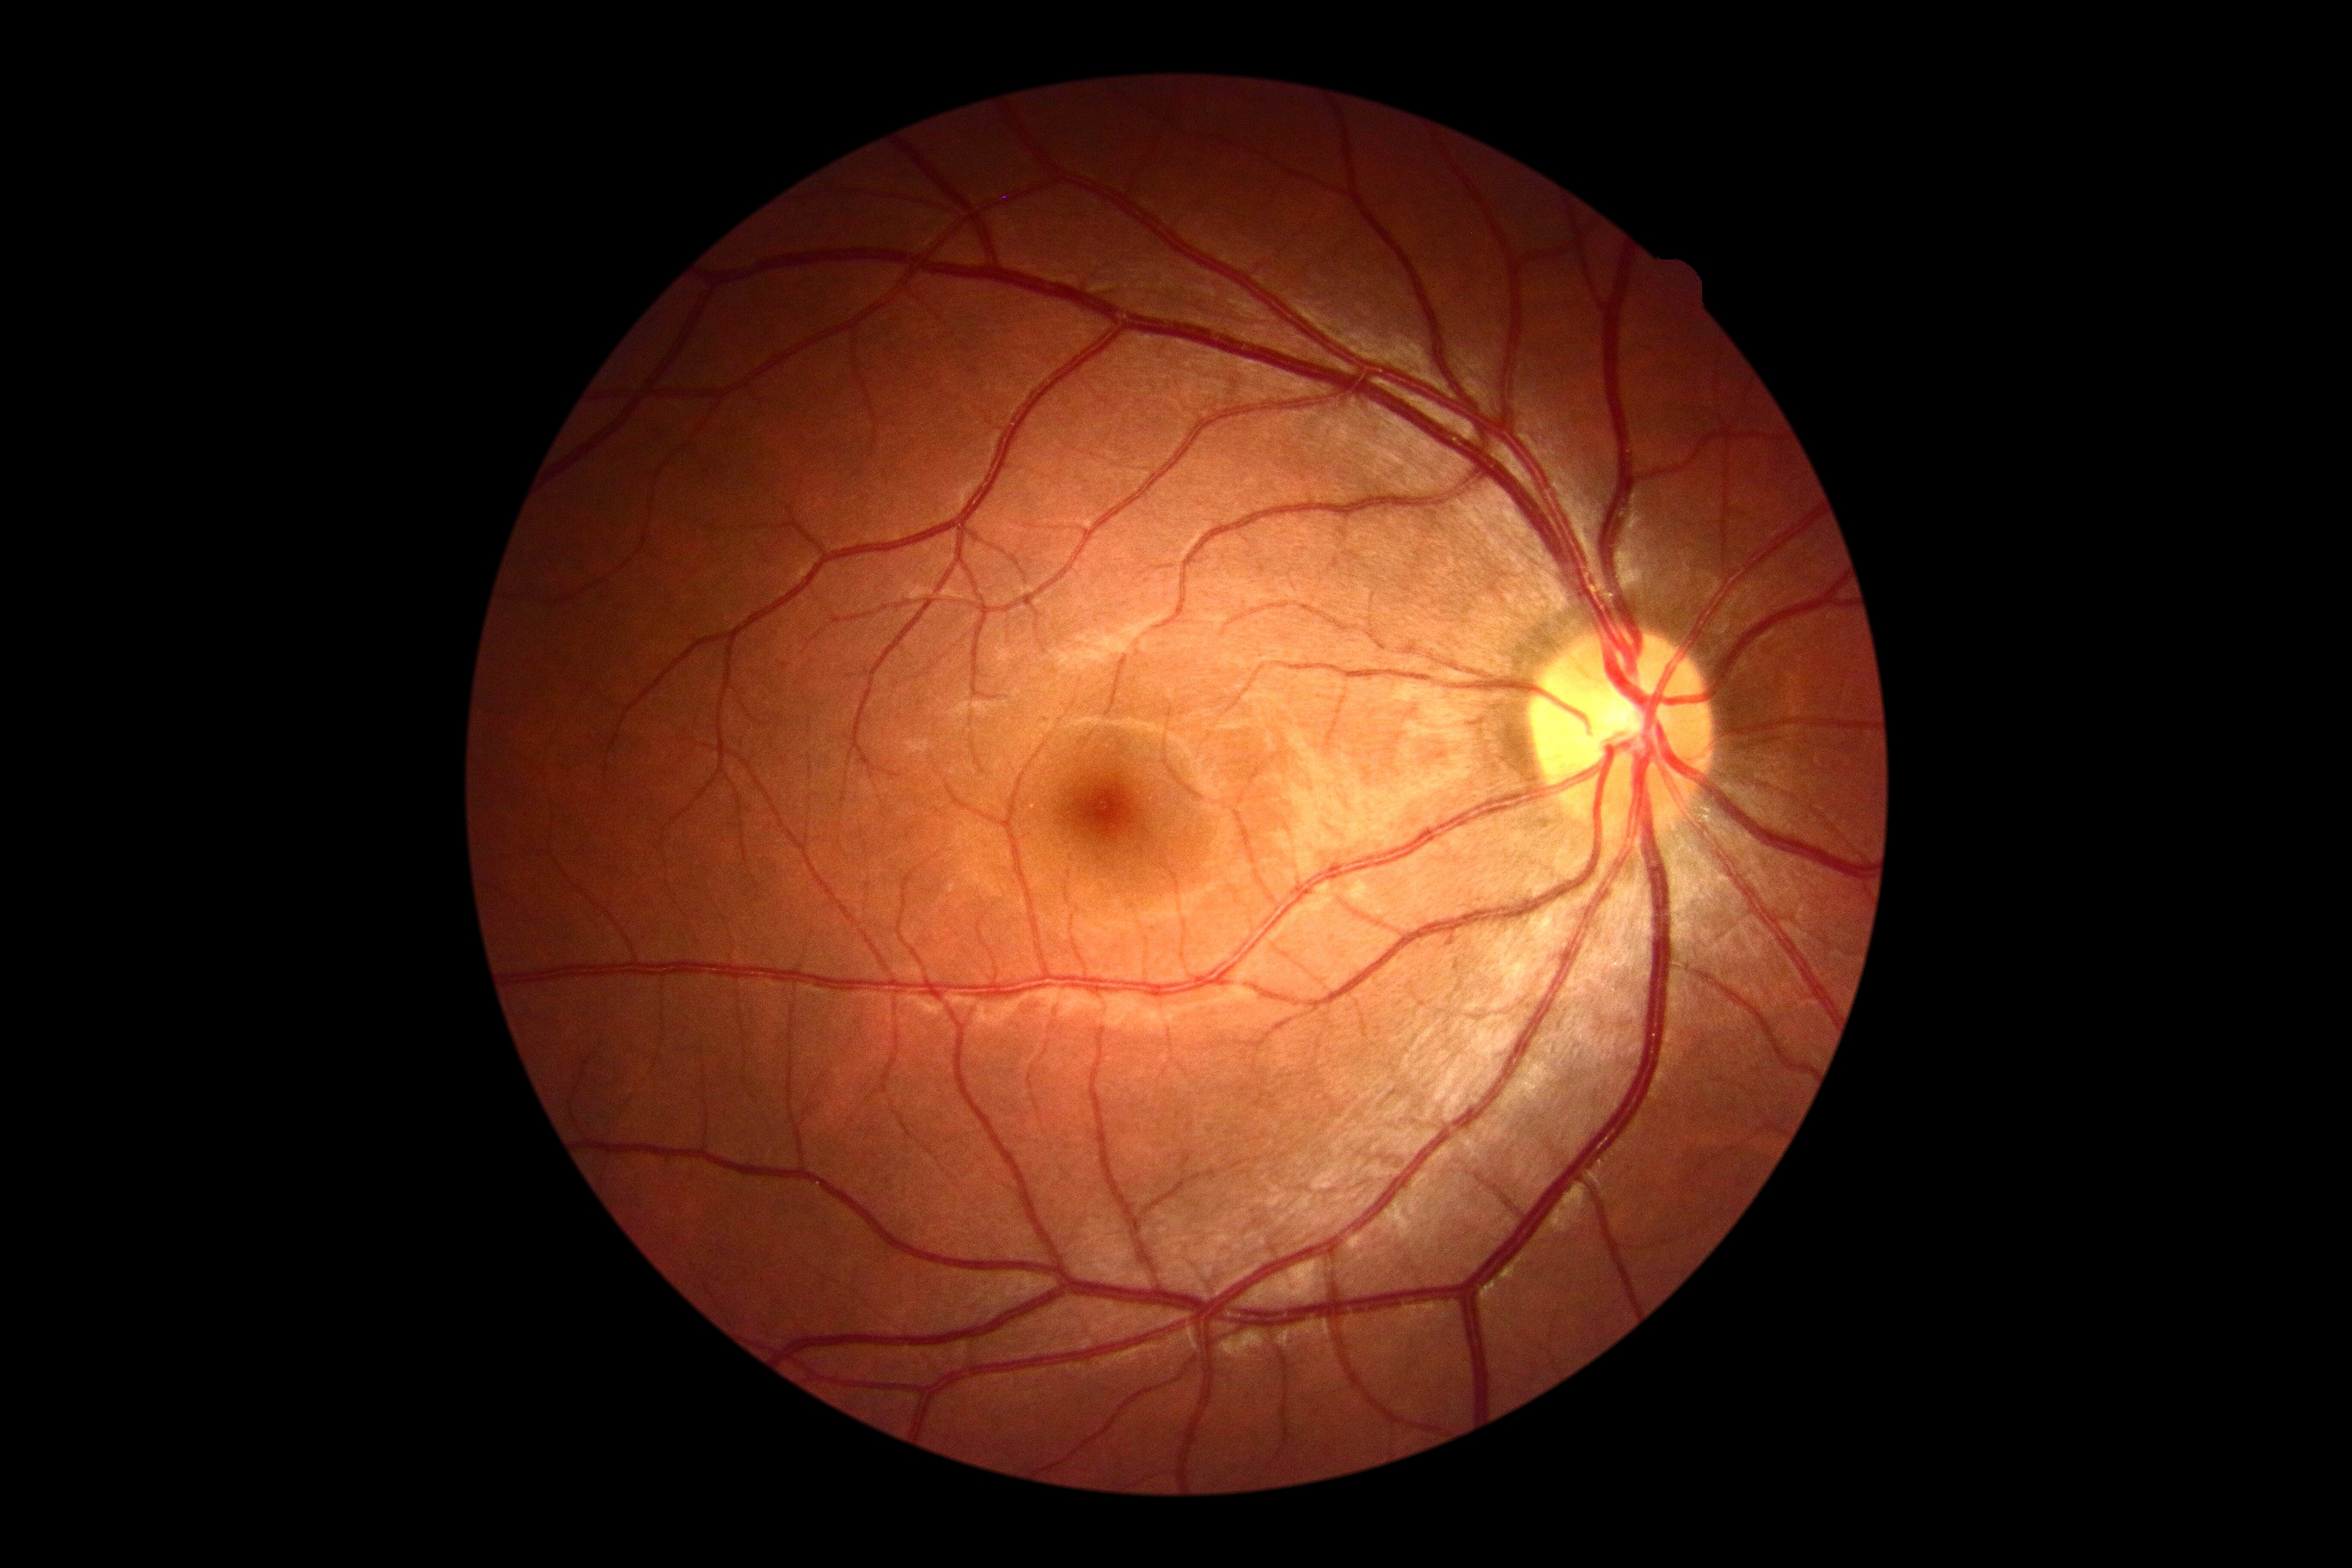

DR: grade 0 (no apparent retinopathy).